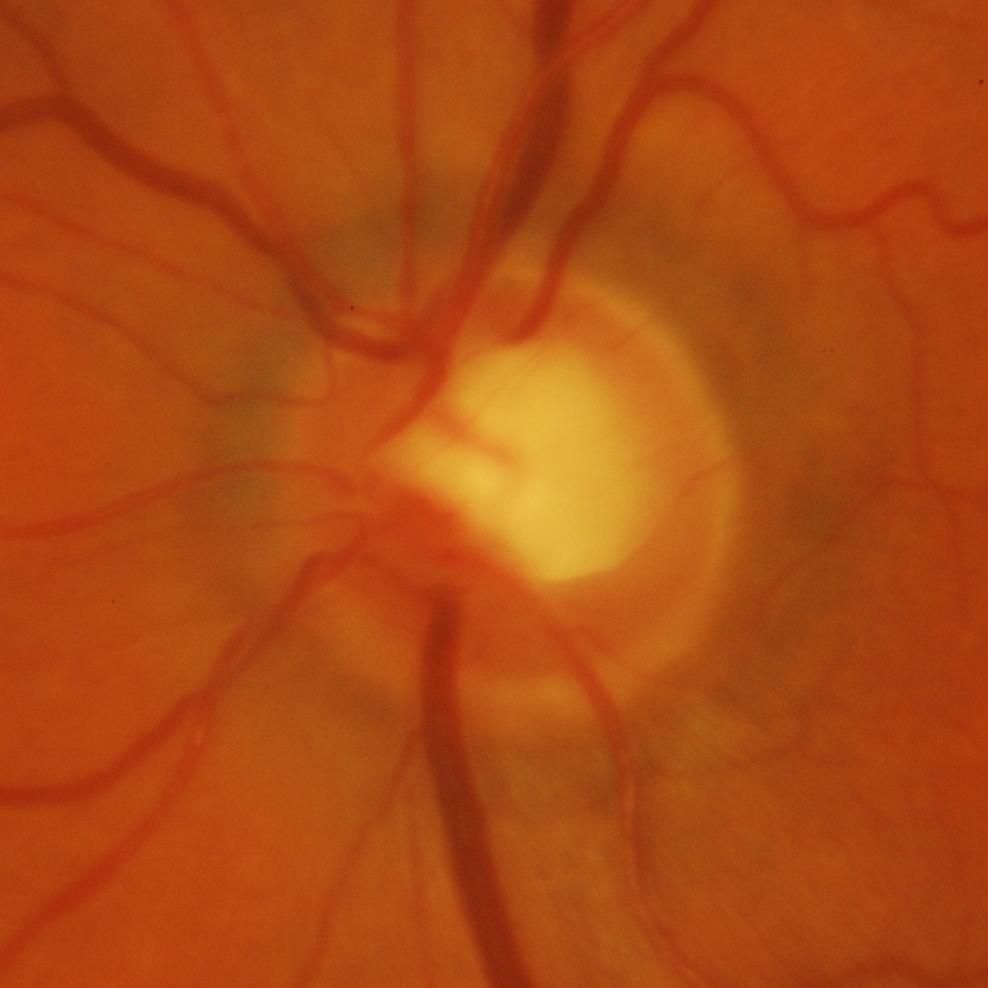 Diagnosis = glaucomatous findings.